Wide-field fundus photograph of an infant
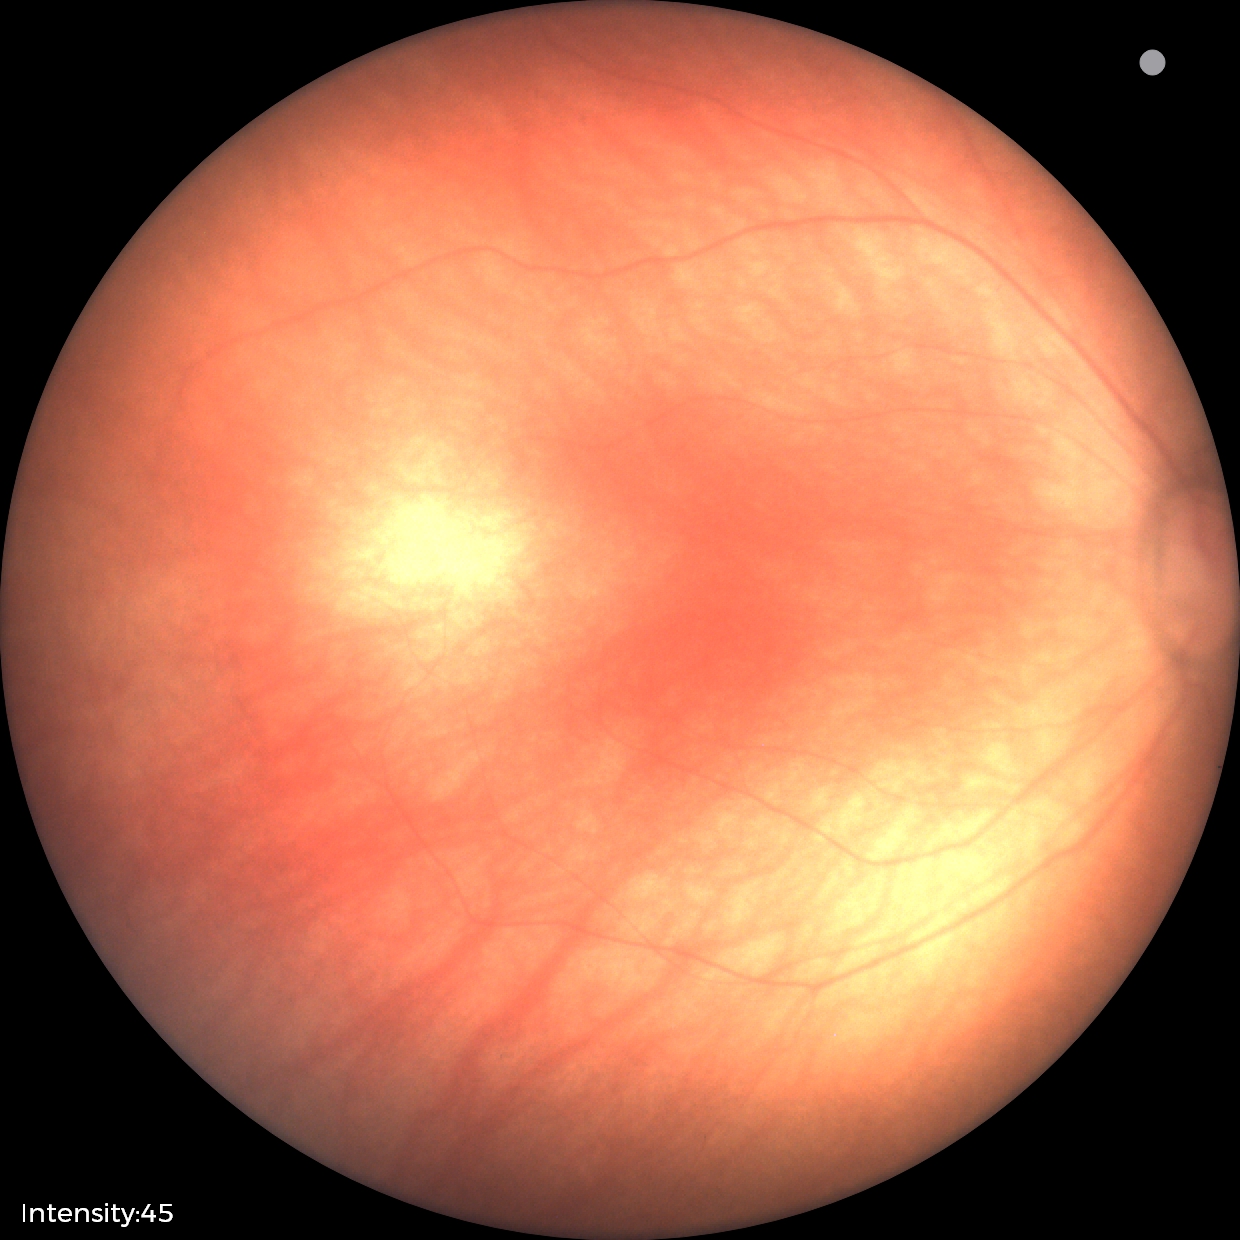 Screening: physiological finding.